FOV: 45 degrees; 2212 x 1659 pixels: 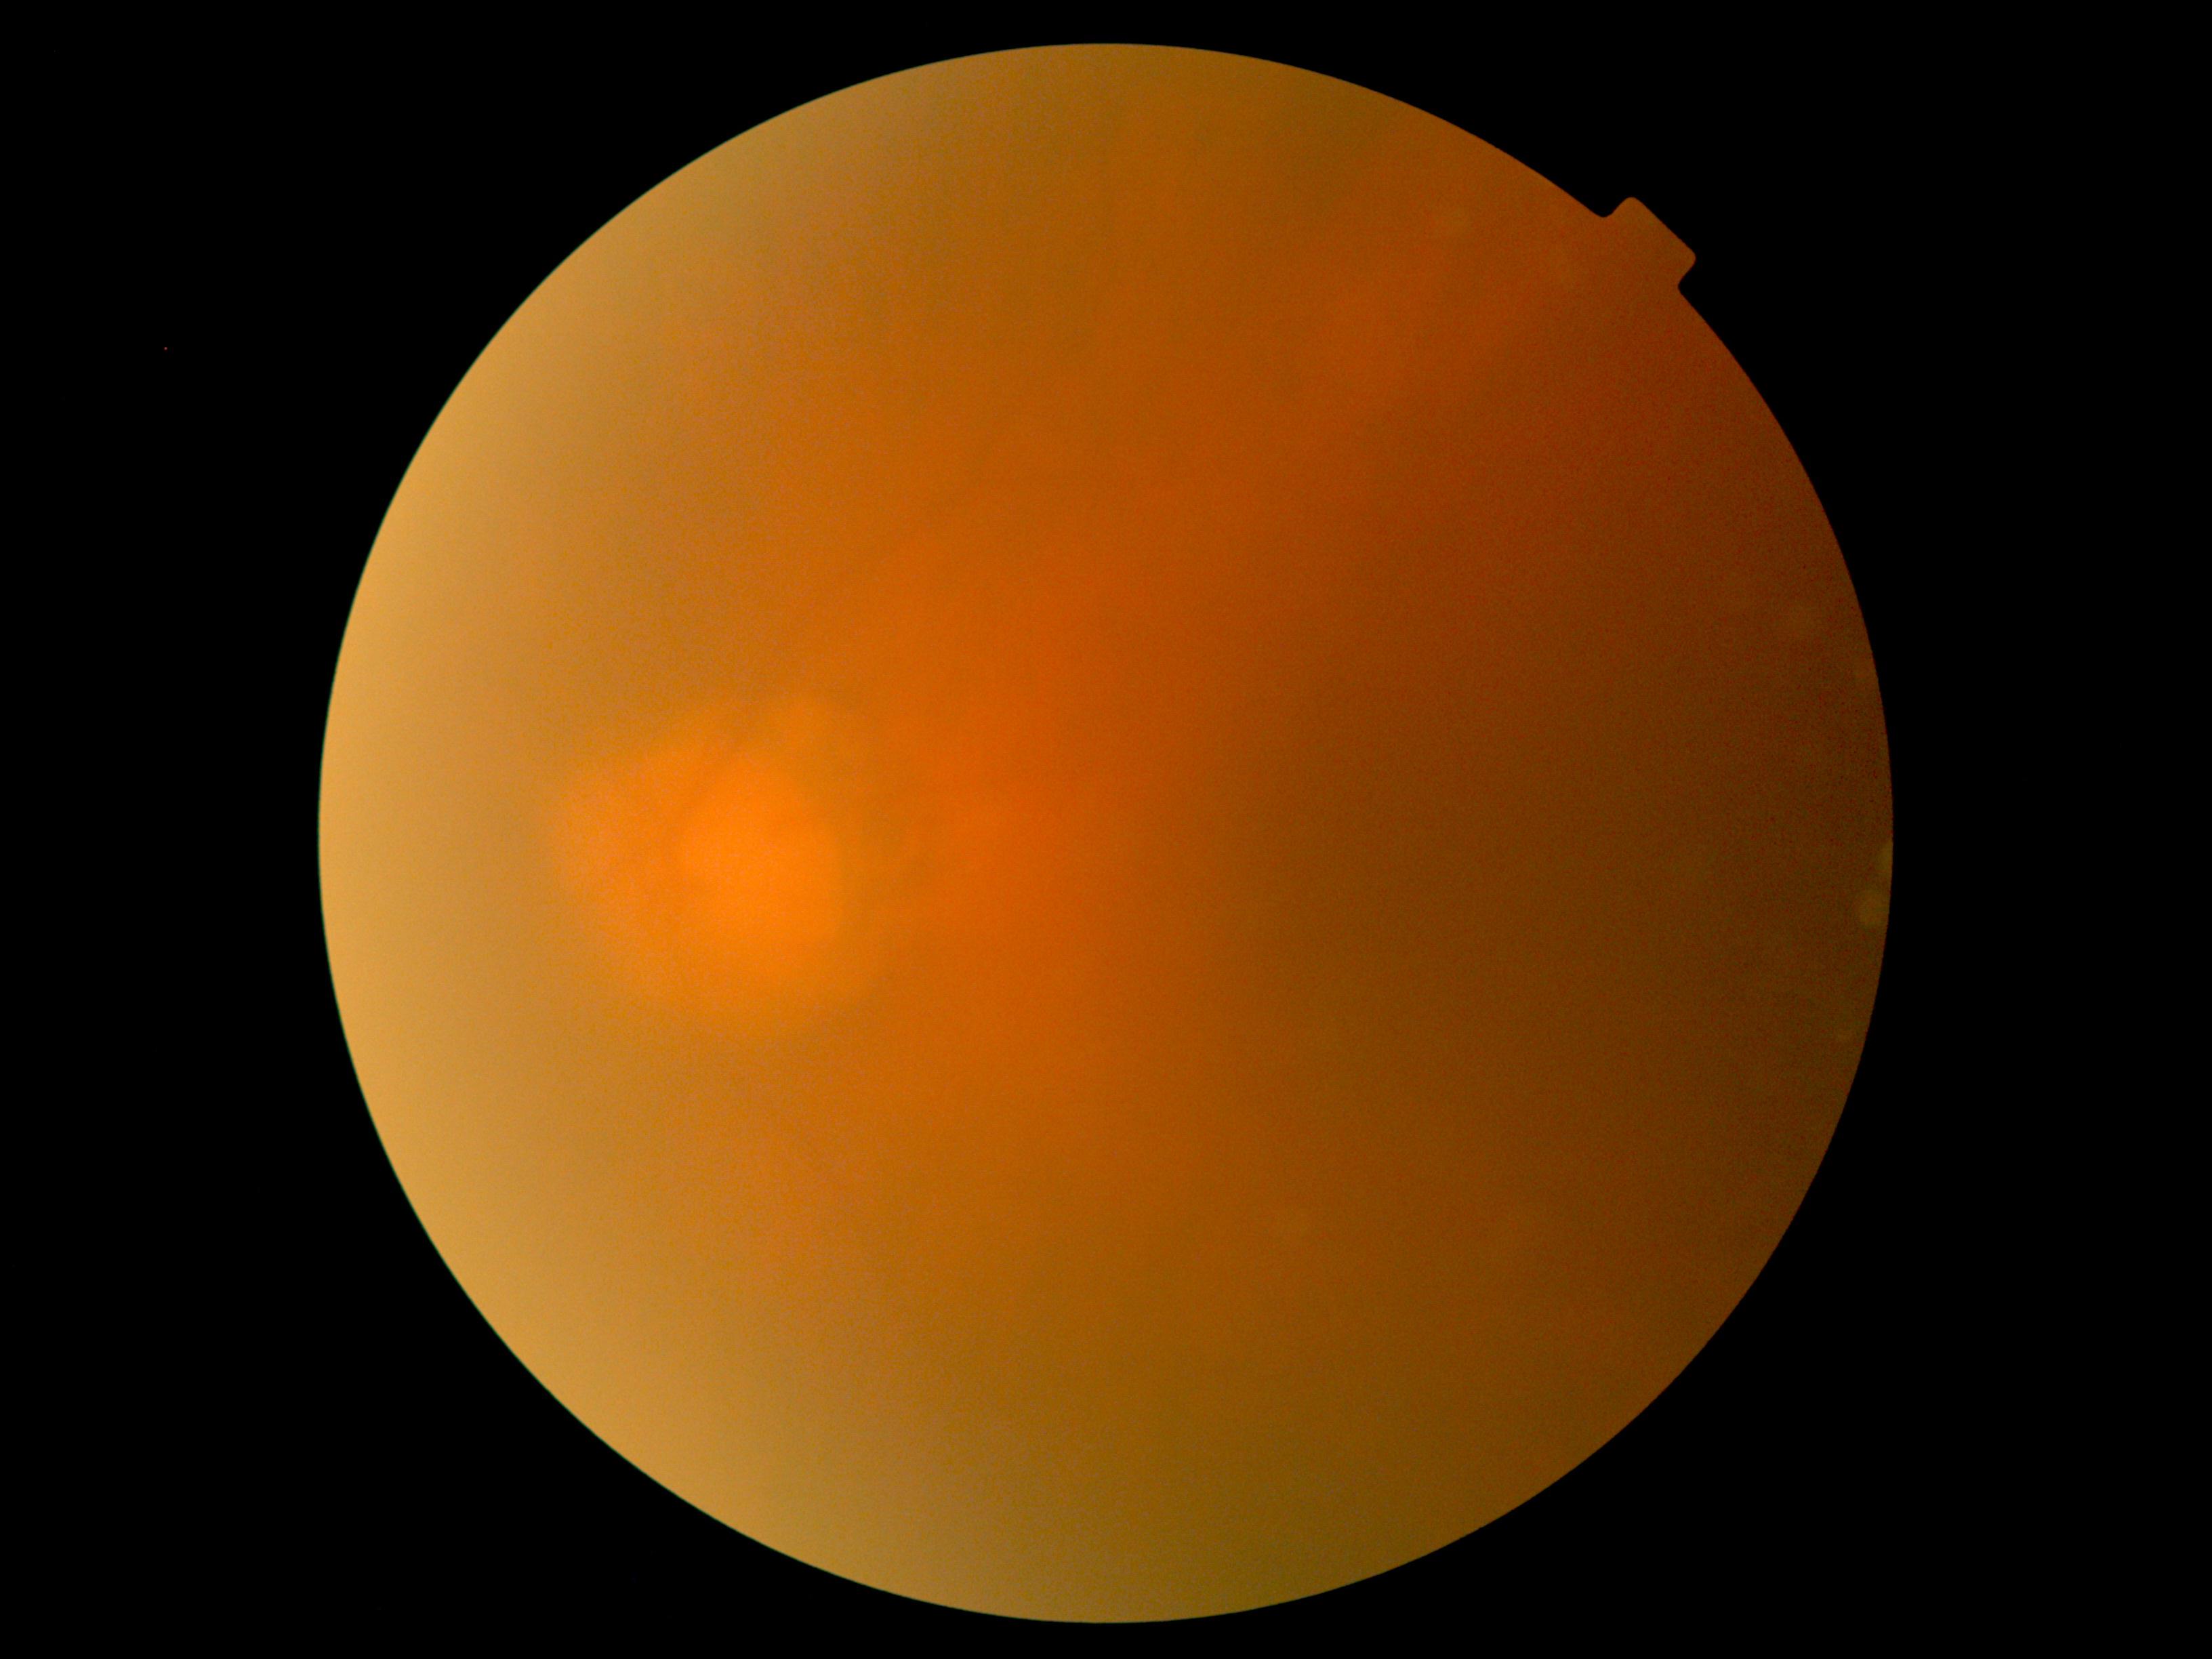

DR grade: ungradable. Quality too poor to assess for DR.